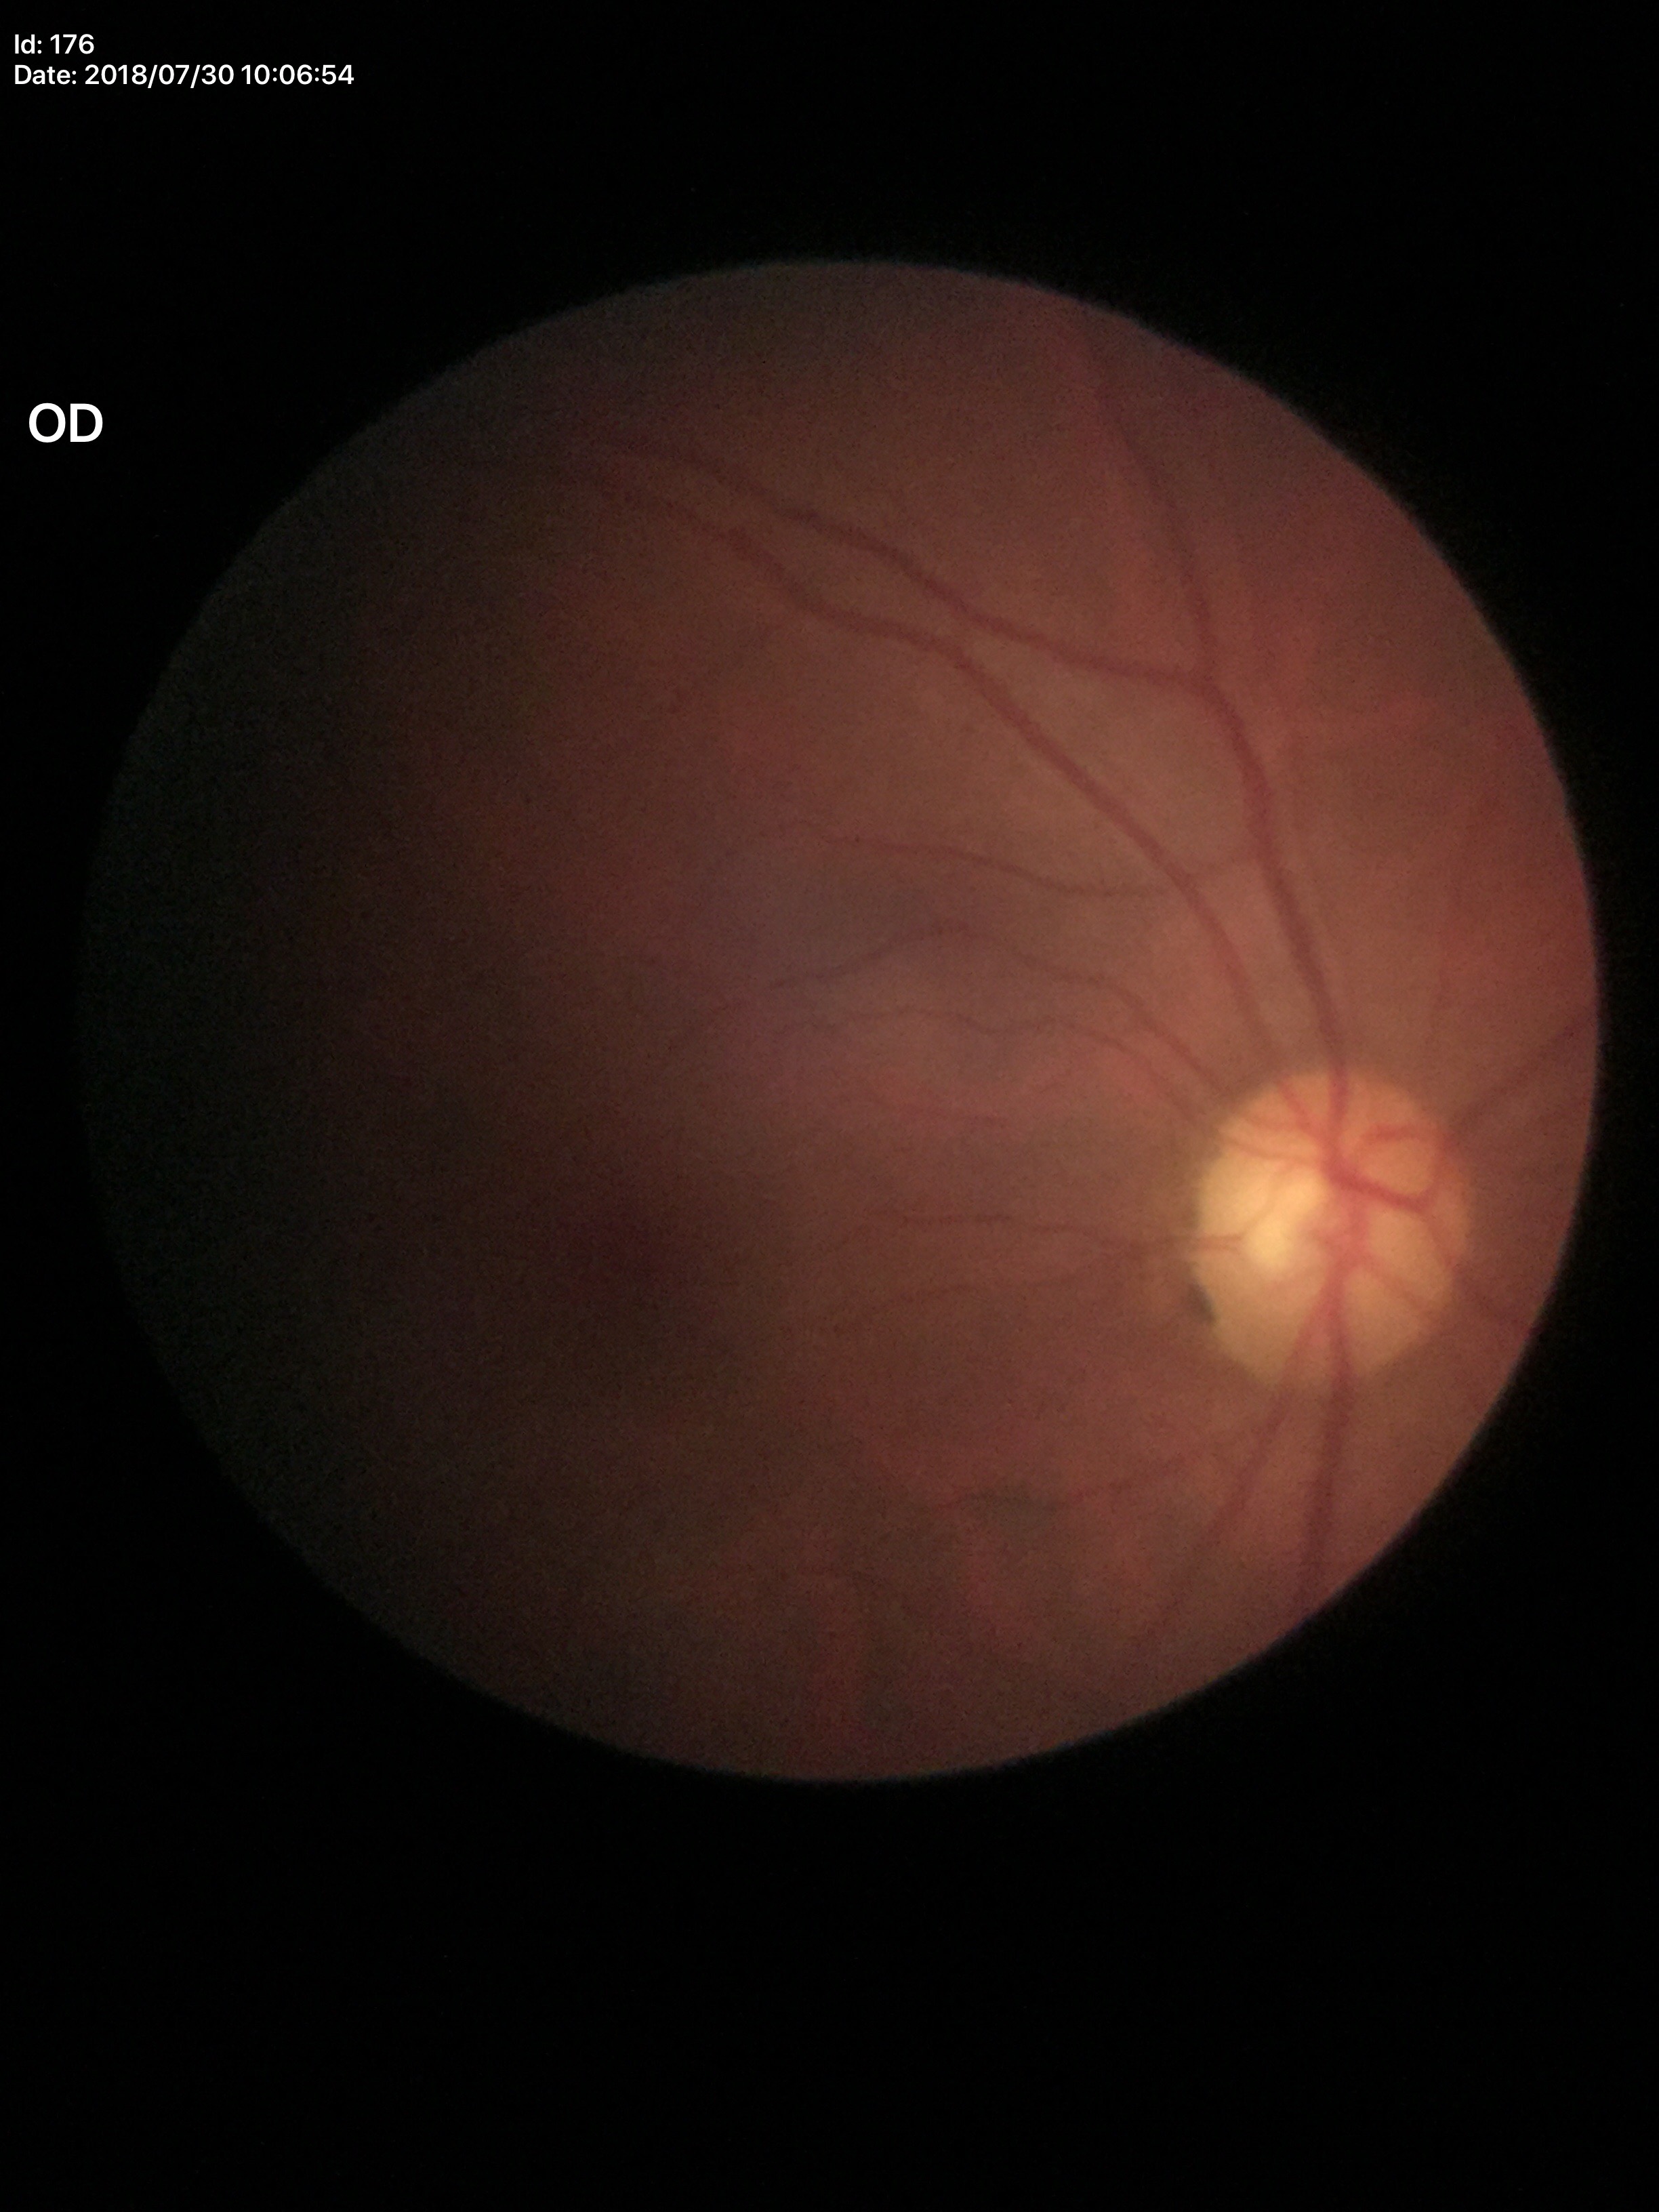
Vertical C/D ratio of 0.55.
No glaucomatous optic neuropathy.
Horizontal CDR of 0.54.